CFP: 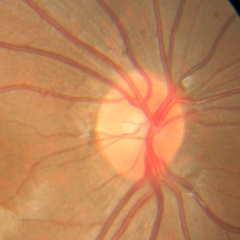 No signs of glaucoma.